Modified Davis grading — 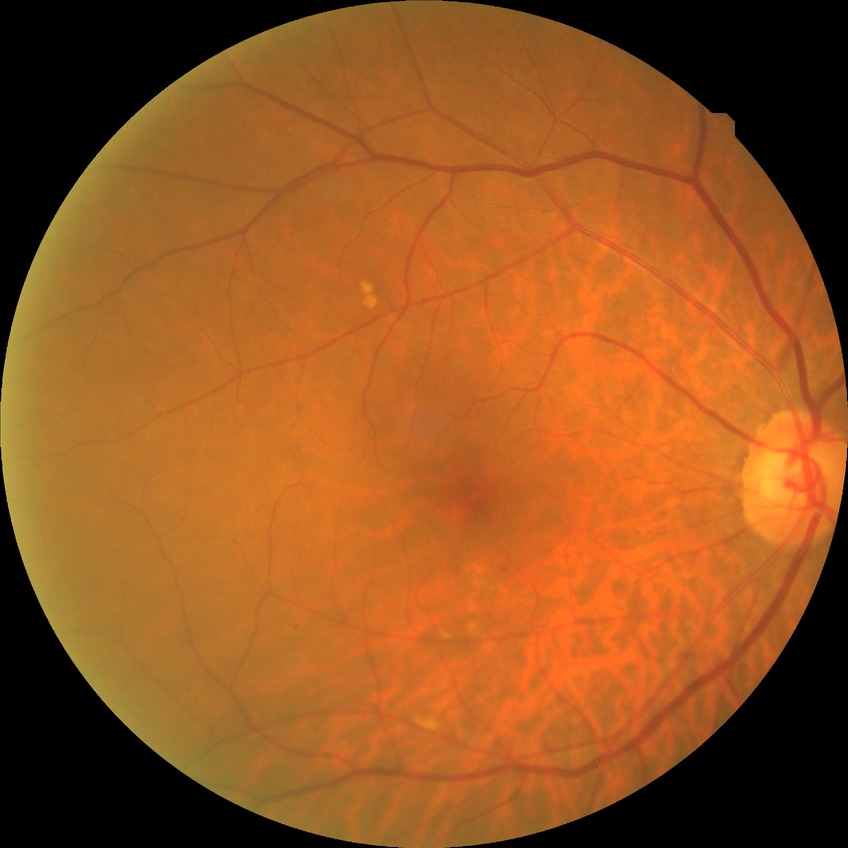

Diabetic retinopathy (DR) is simple diabetic retinopathy (SDR).